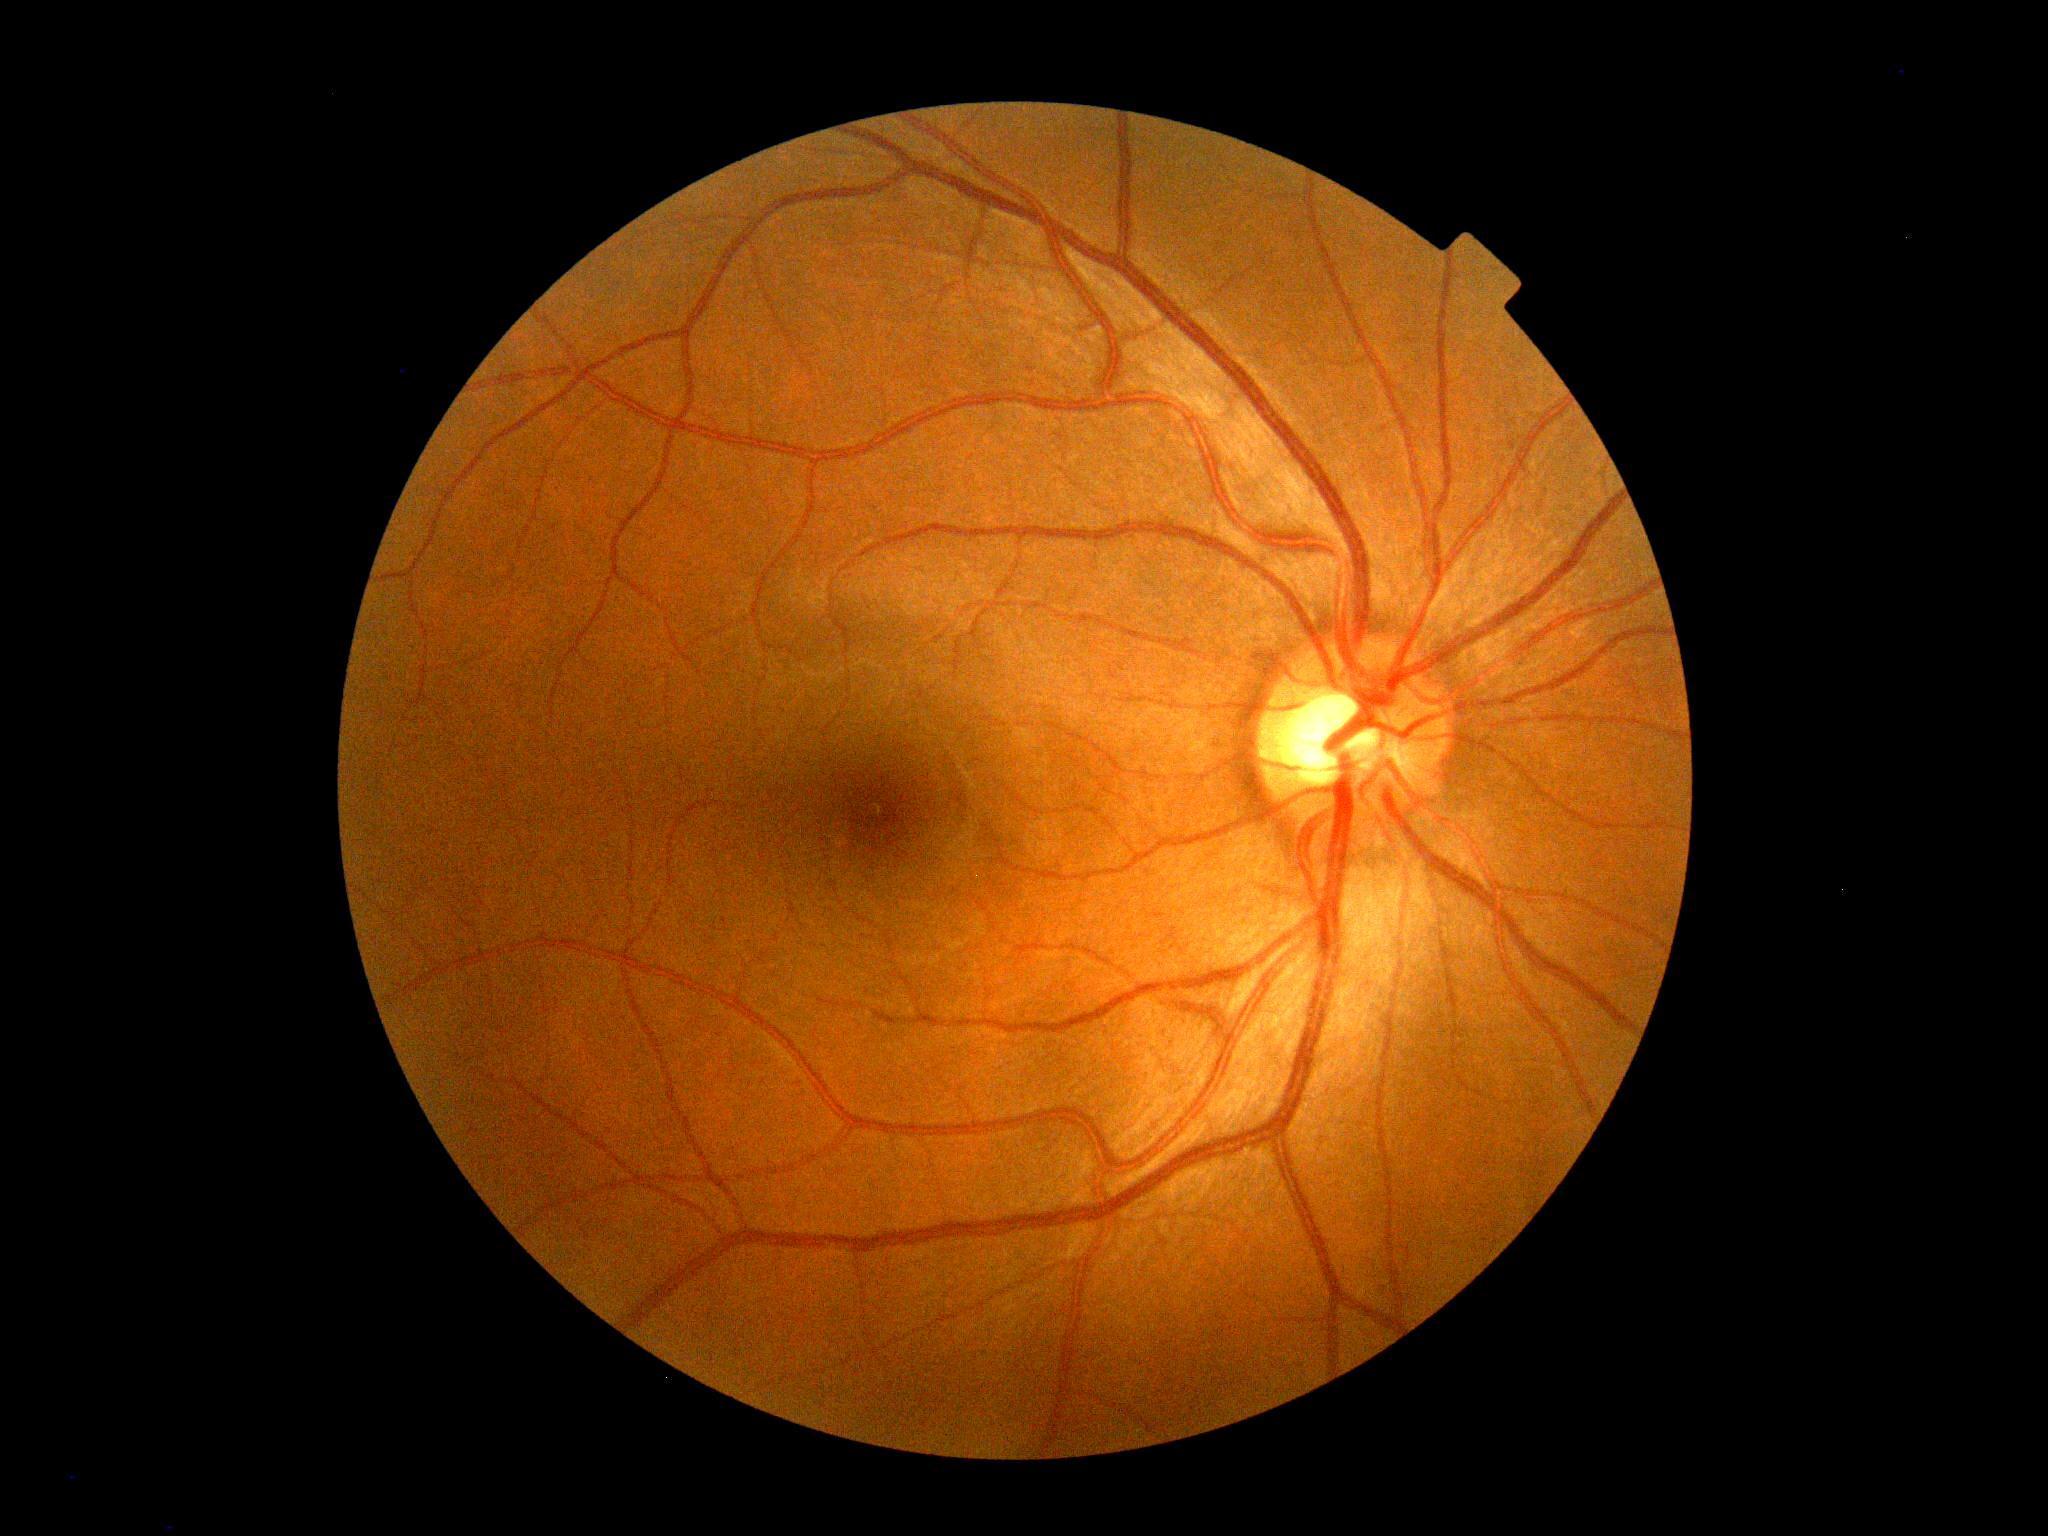
diabetic retinopathy (DR)@grade 0.